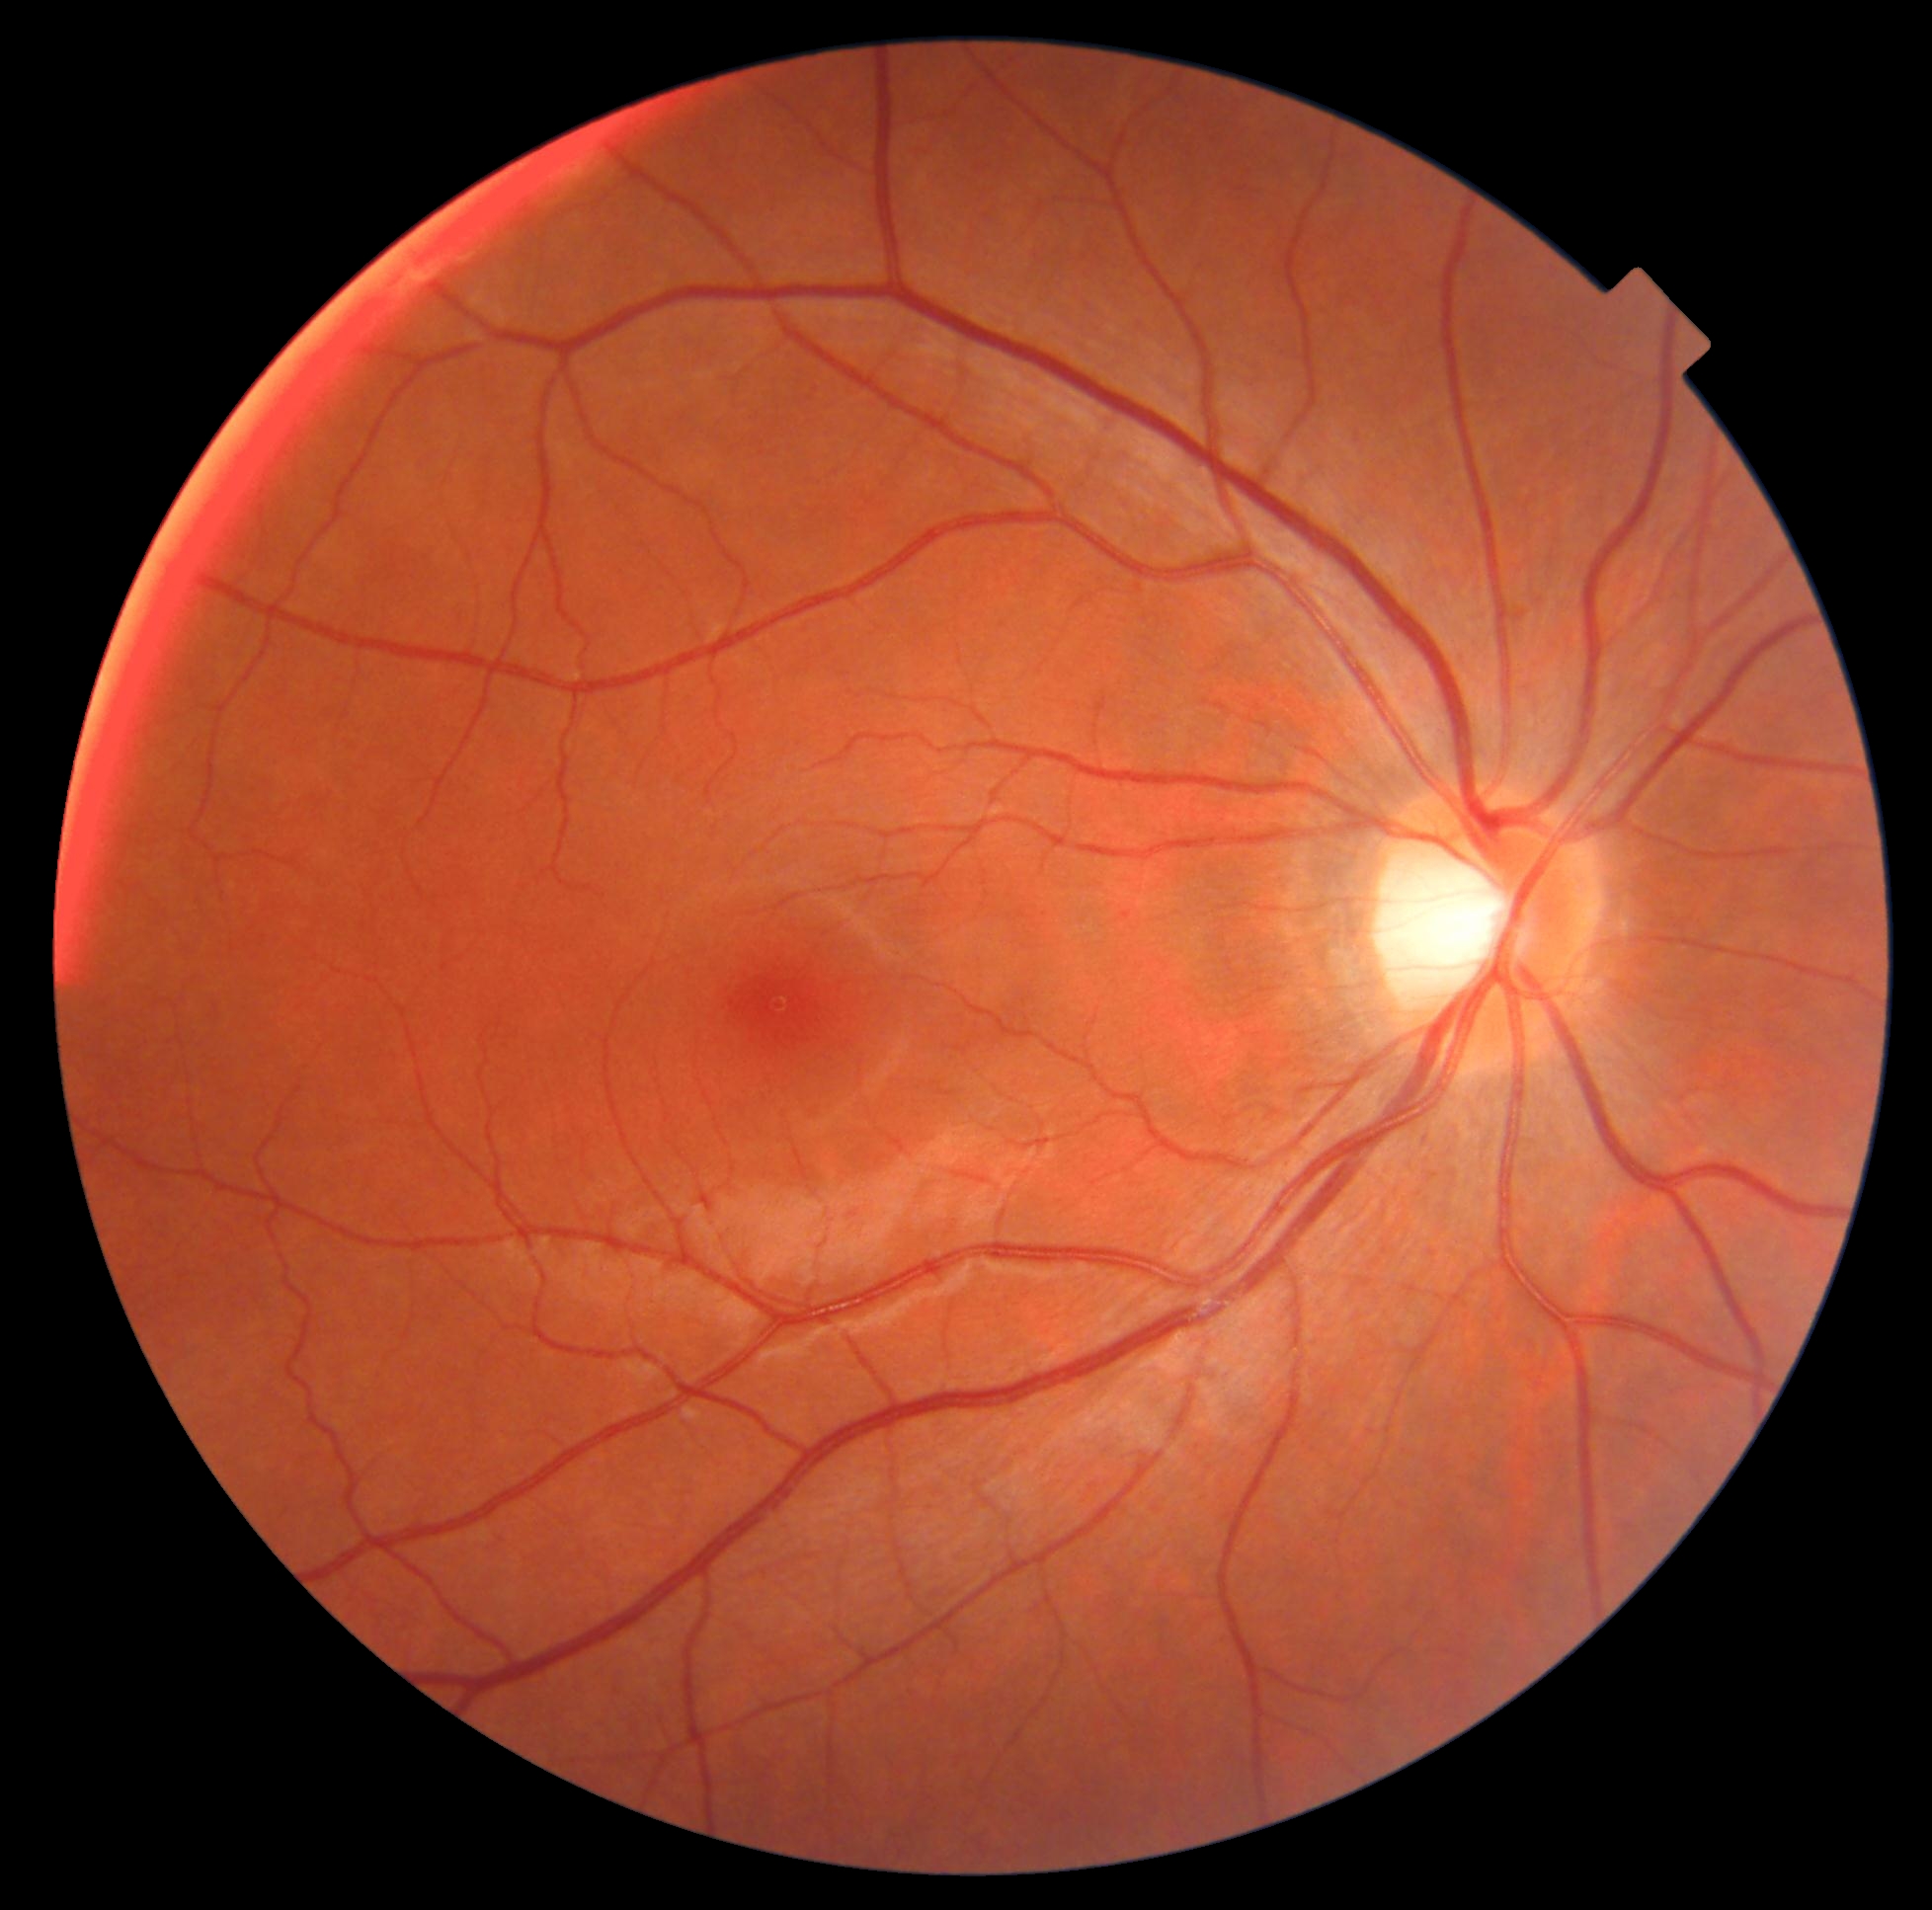
Retinopathy: grade 0. No DR findings.